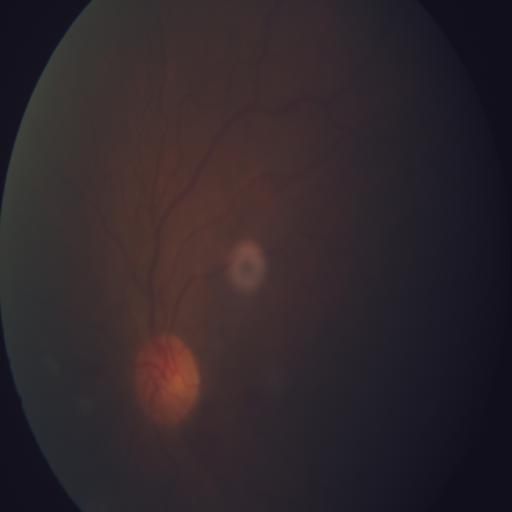

Pathology: ST (optociliary shunt).